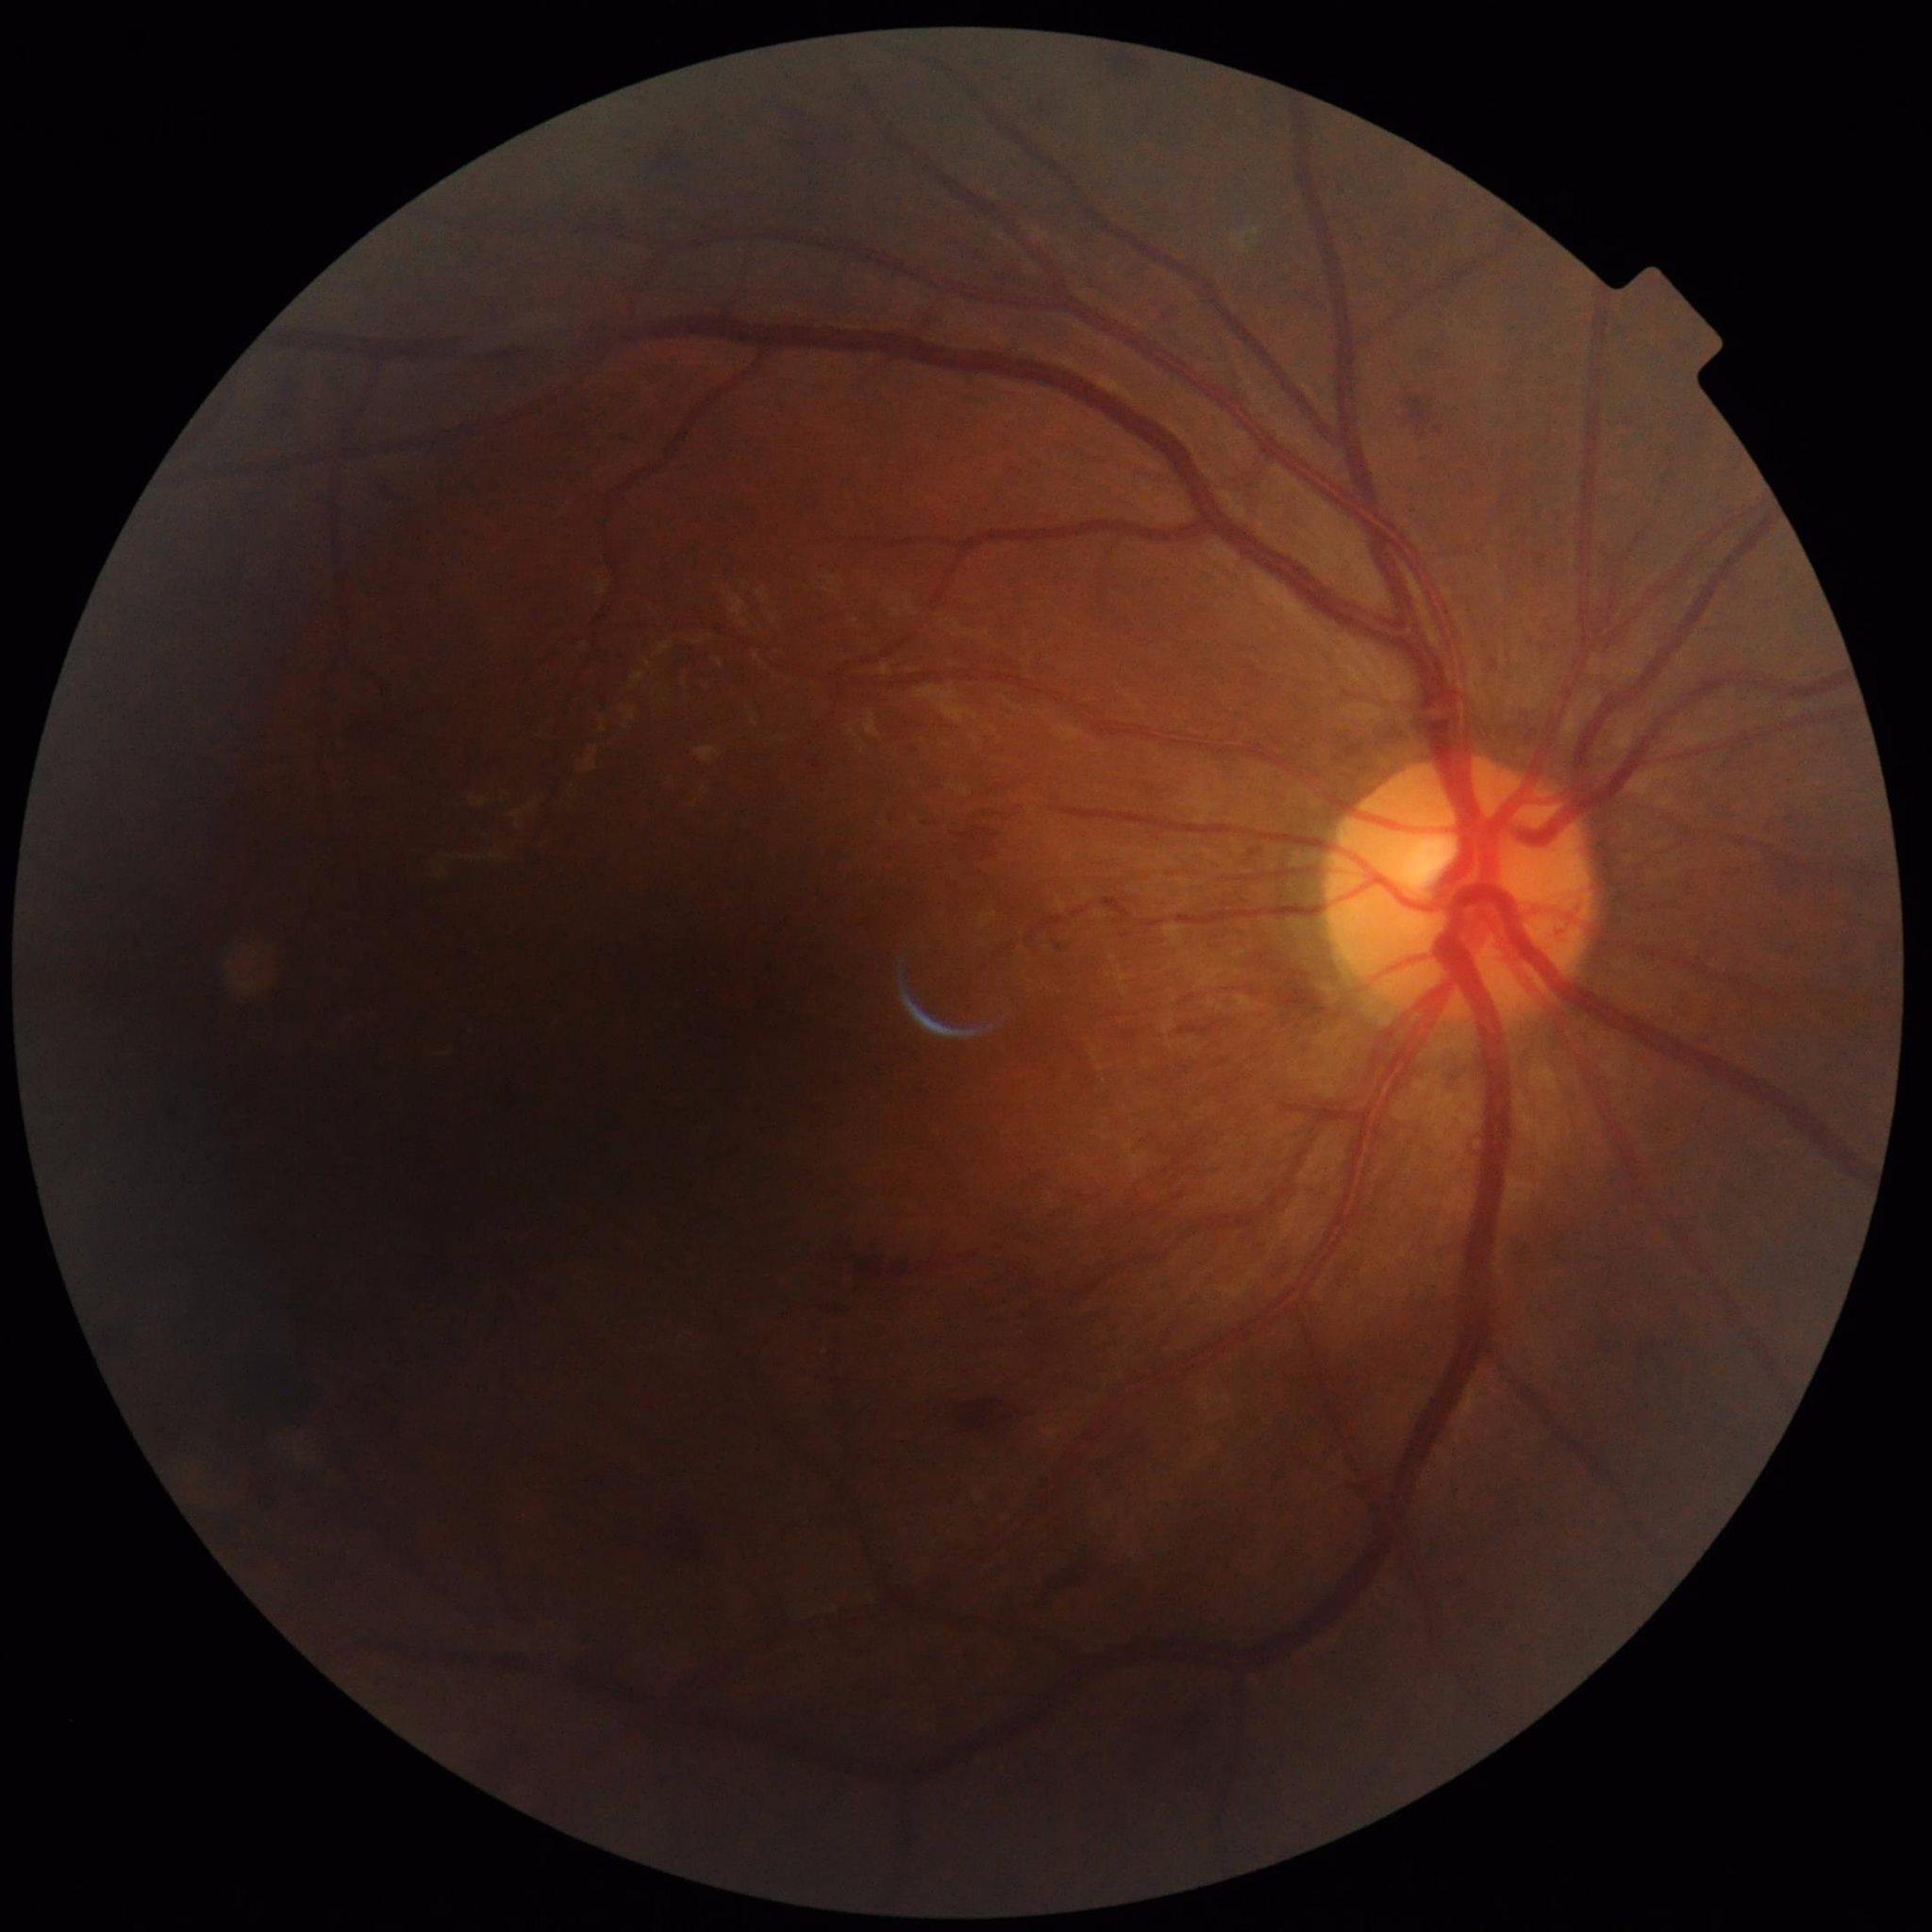 Disease: diabetic retinopathy (DR).